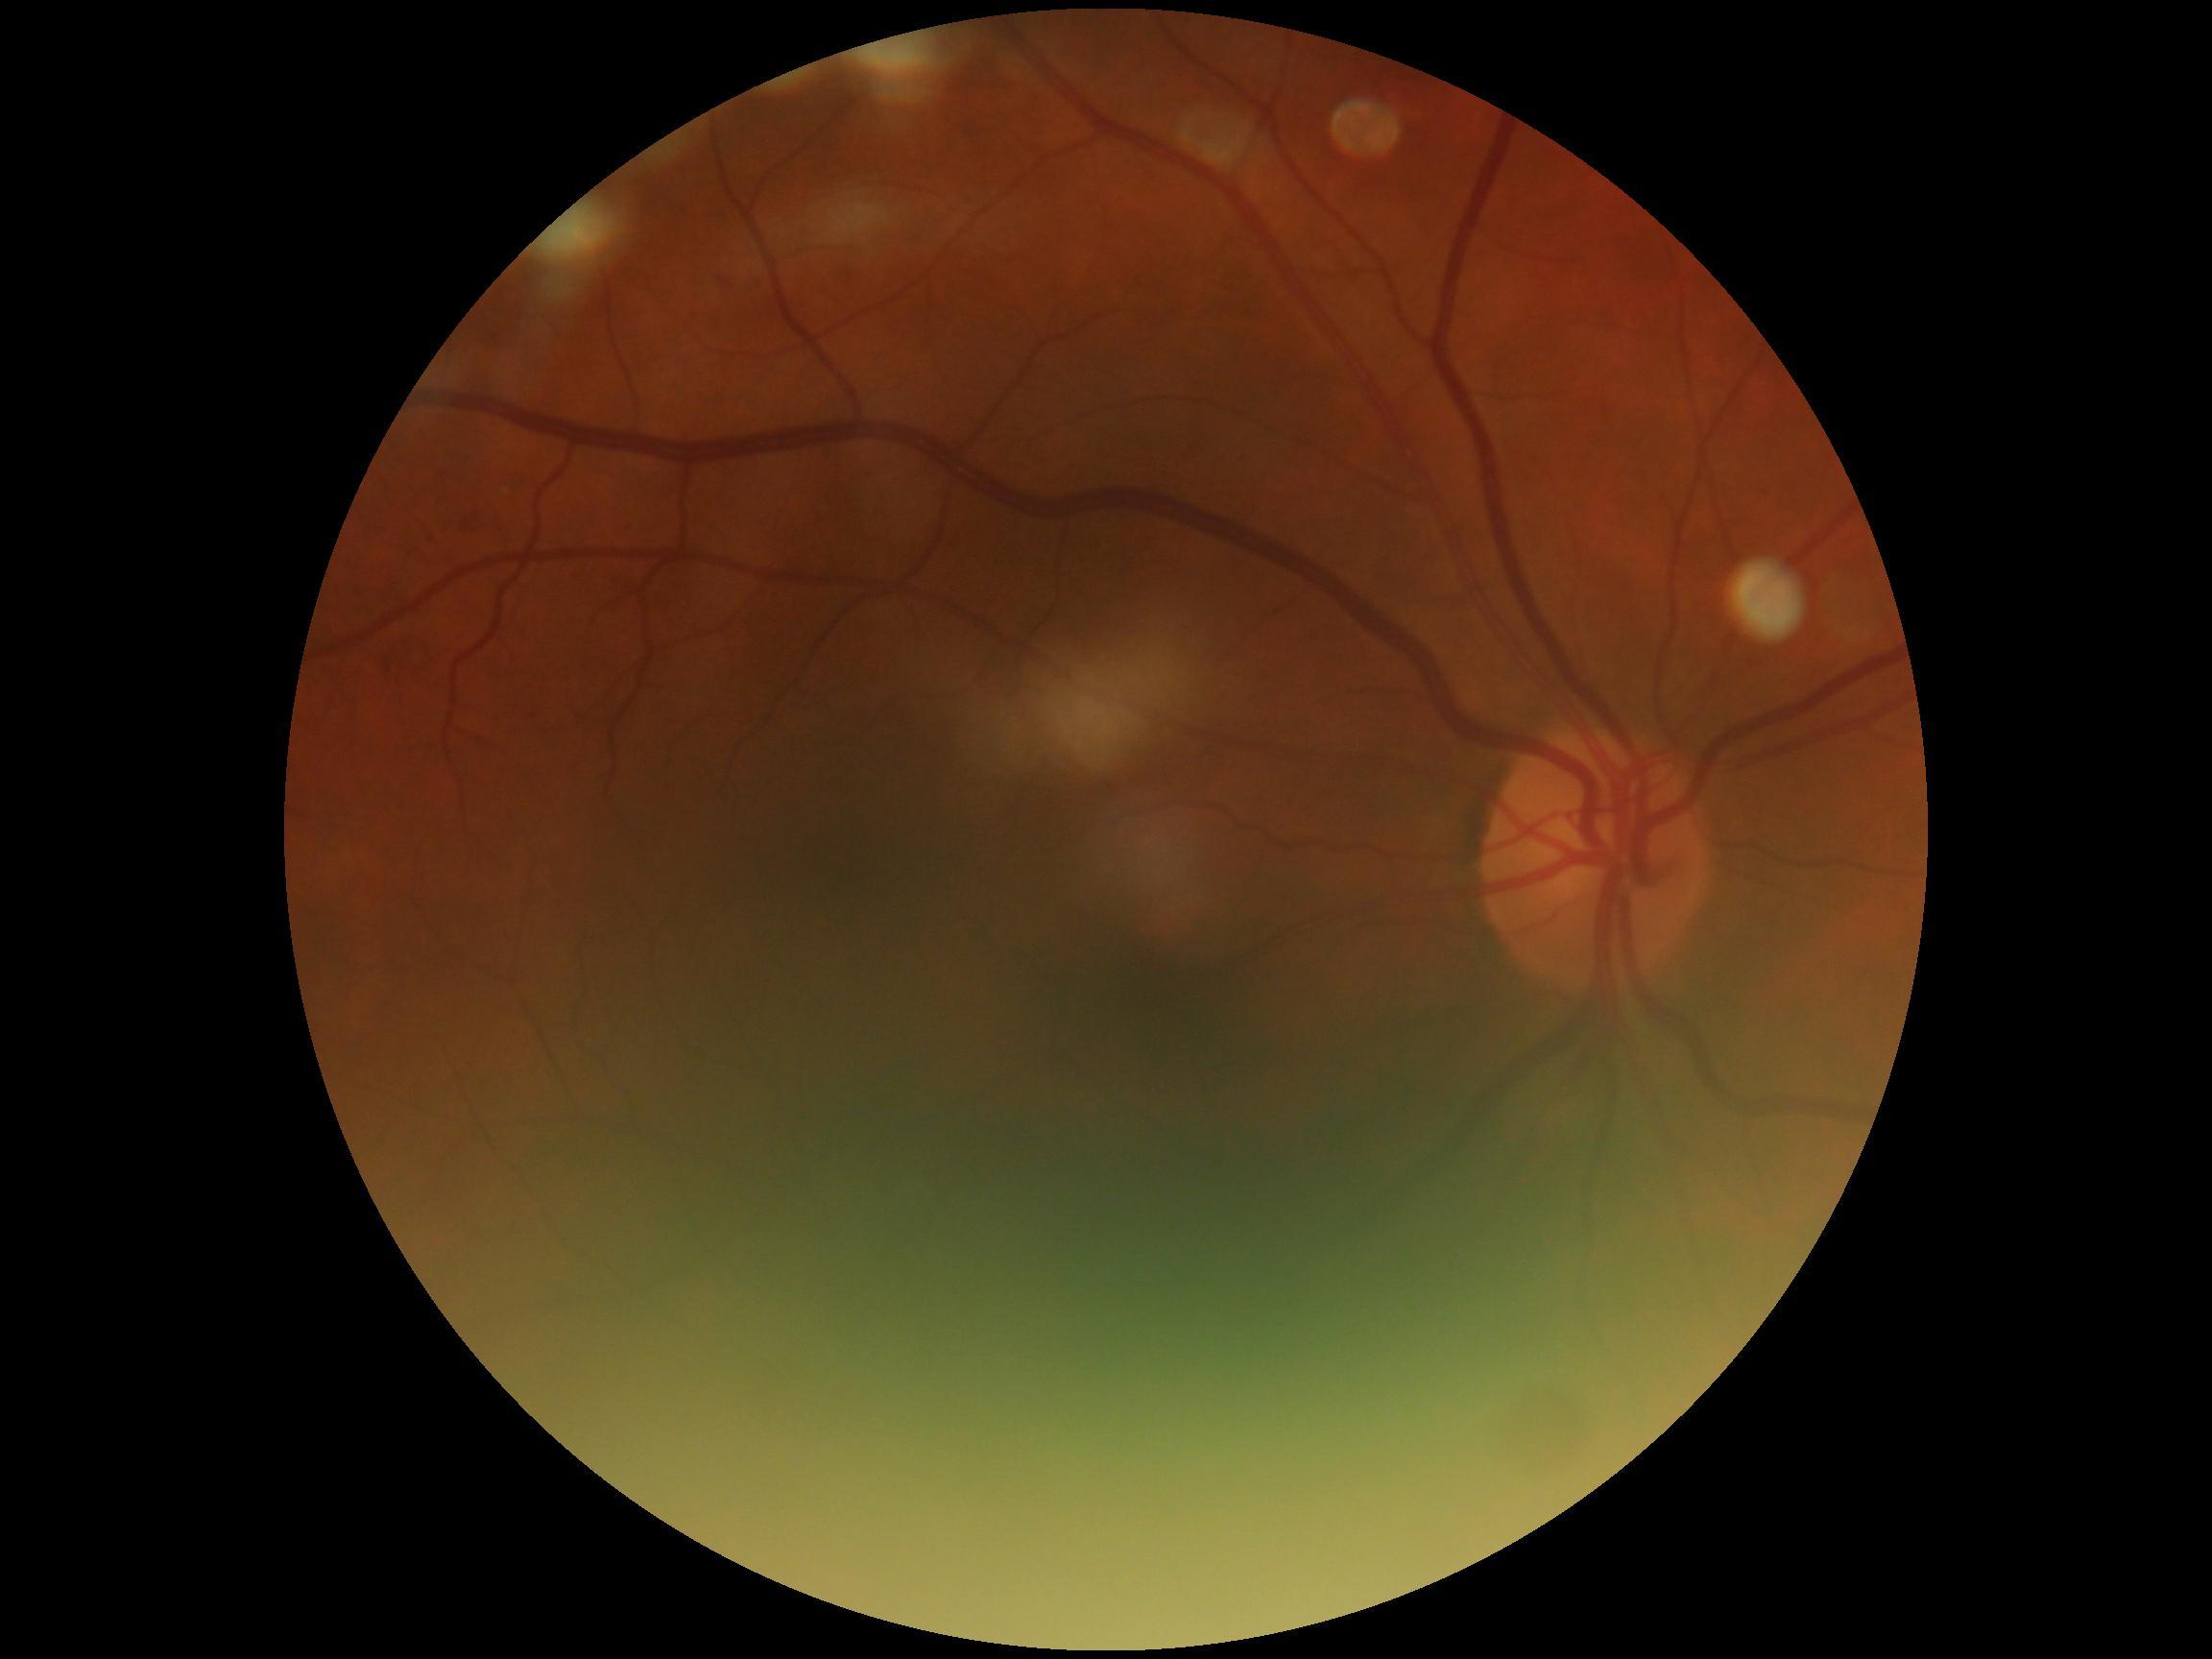

retinopathy = 2/4.